412x310px; color fundus image:
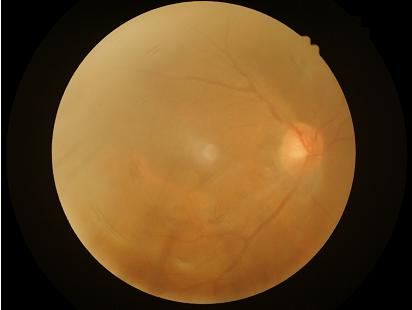
Narrow intensity range; structures are hard to distinguish. Overall image quality is poor. There is over- or under-exposure or a color cast. Noticeable blur in the optic disc, vessels, or background.